Dilated pupil; 35° FOV before cropping; optic disc photograph.
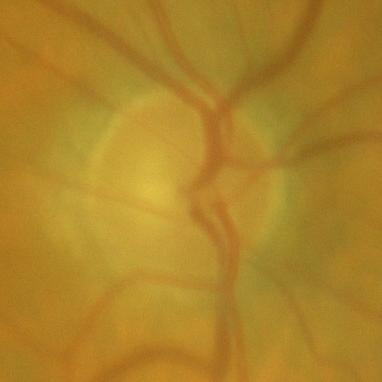
Consistent with no glaucomatous damage.